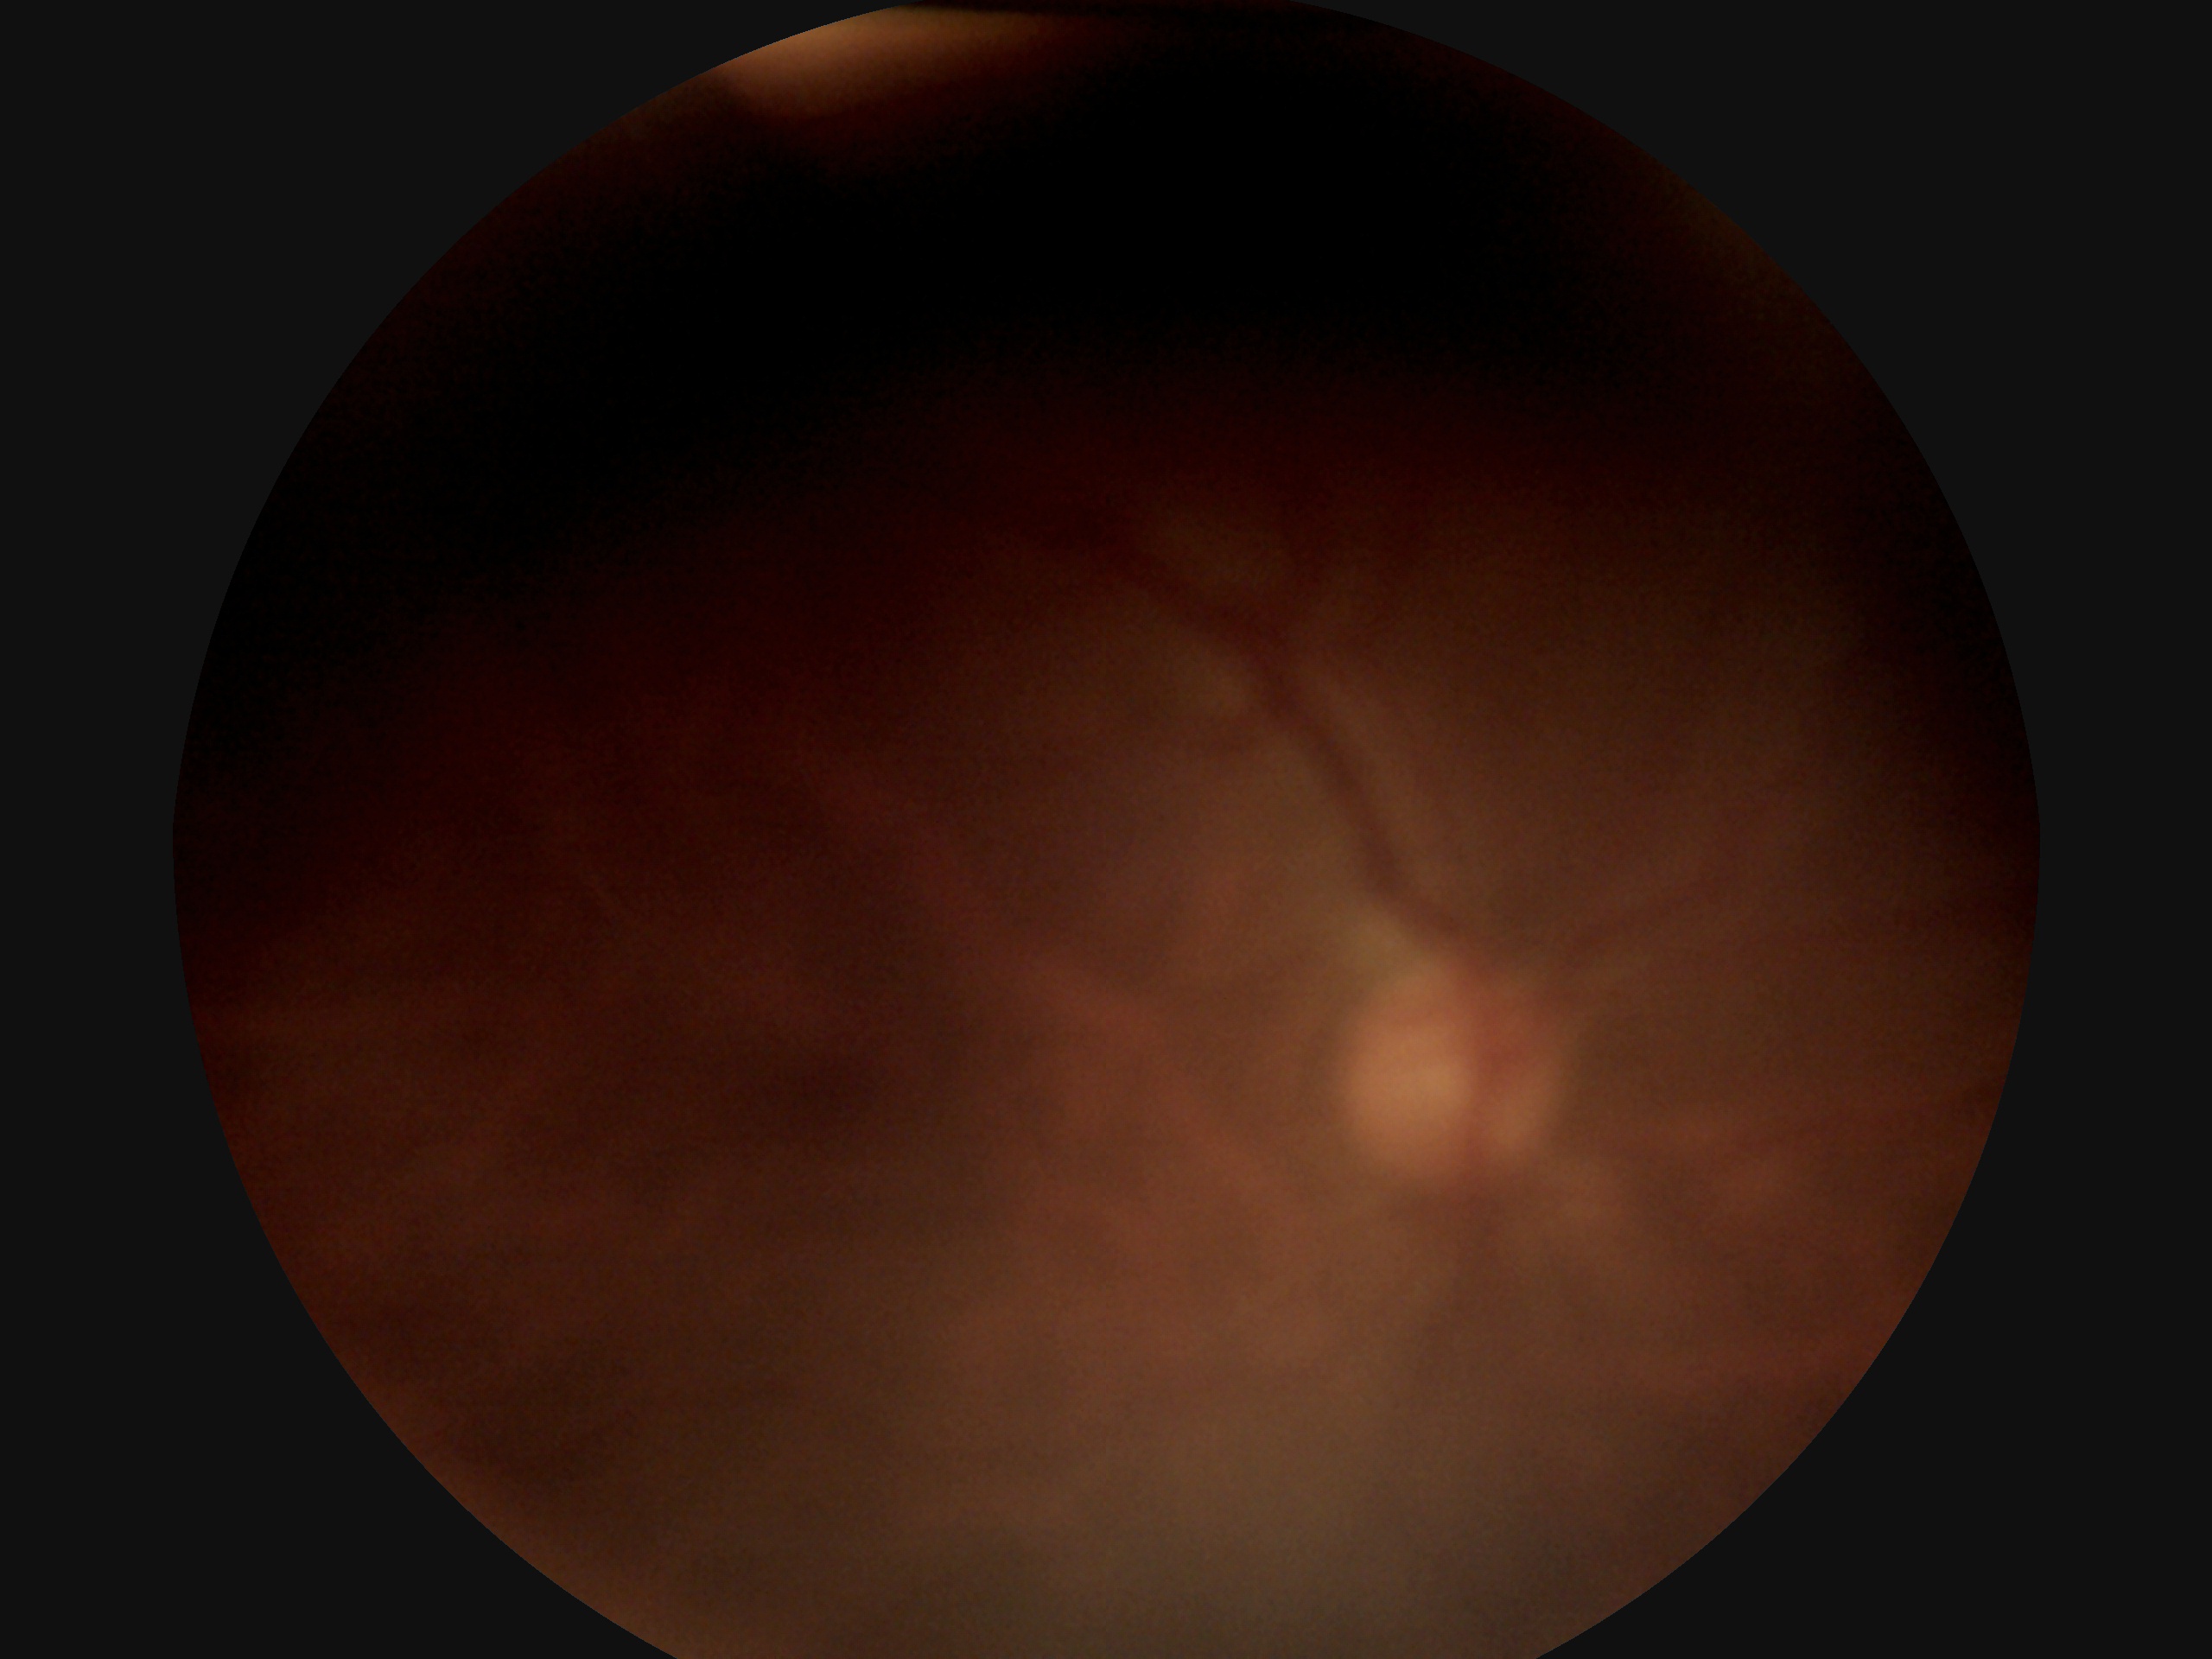 * diabetic retinopathy (DR) — ungradable